Infant wide-field retinal image · 640x480: 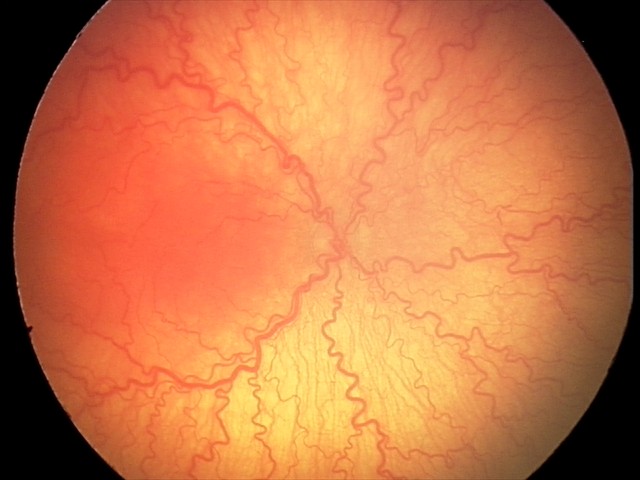
From an examination with diagnosis of A-ROP (aggressive ROP) — rapidly progressive severe ROP with prominent plus disease, often without classic stage progression.
Plus disease was diagnosed.